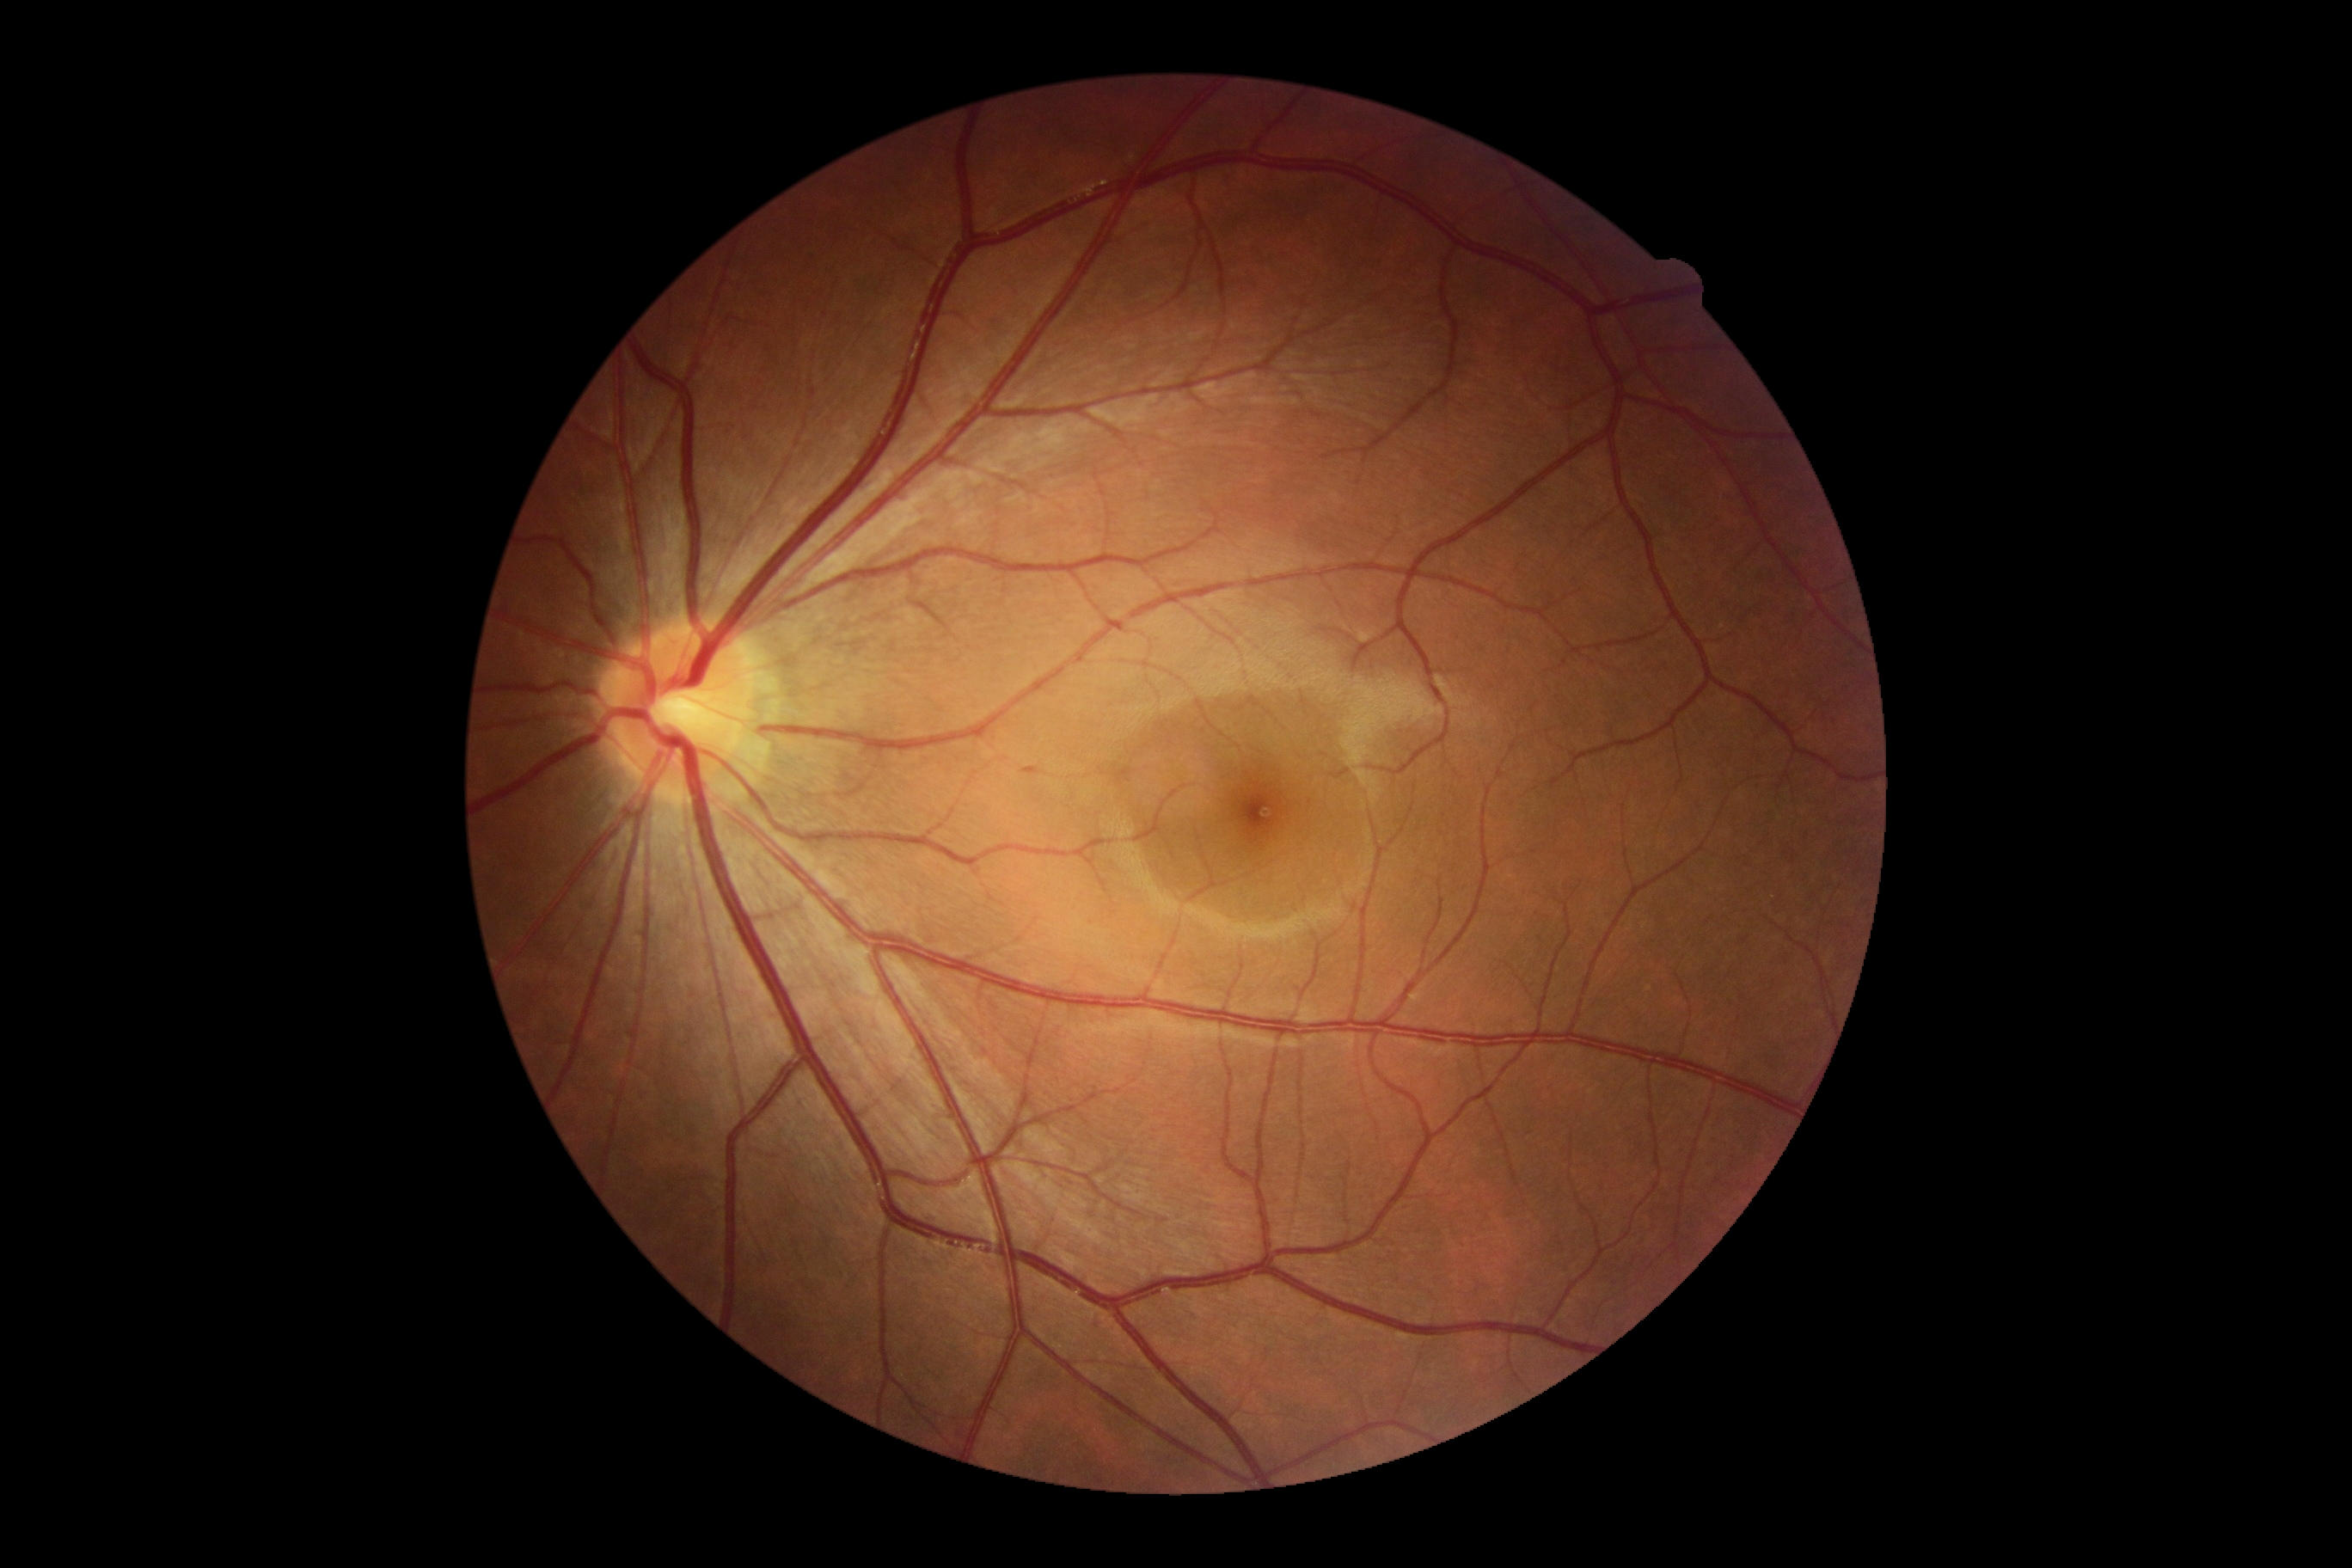

Annotations:
– diabetic retinopathy (DR) — no apparent diabetic retinopathy (grade 0)